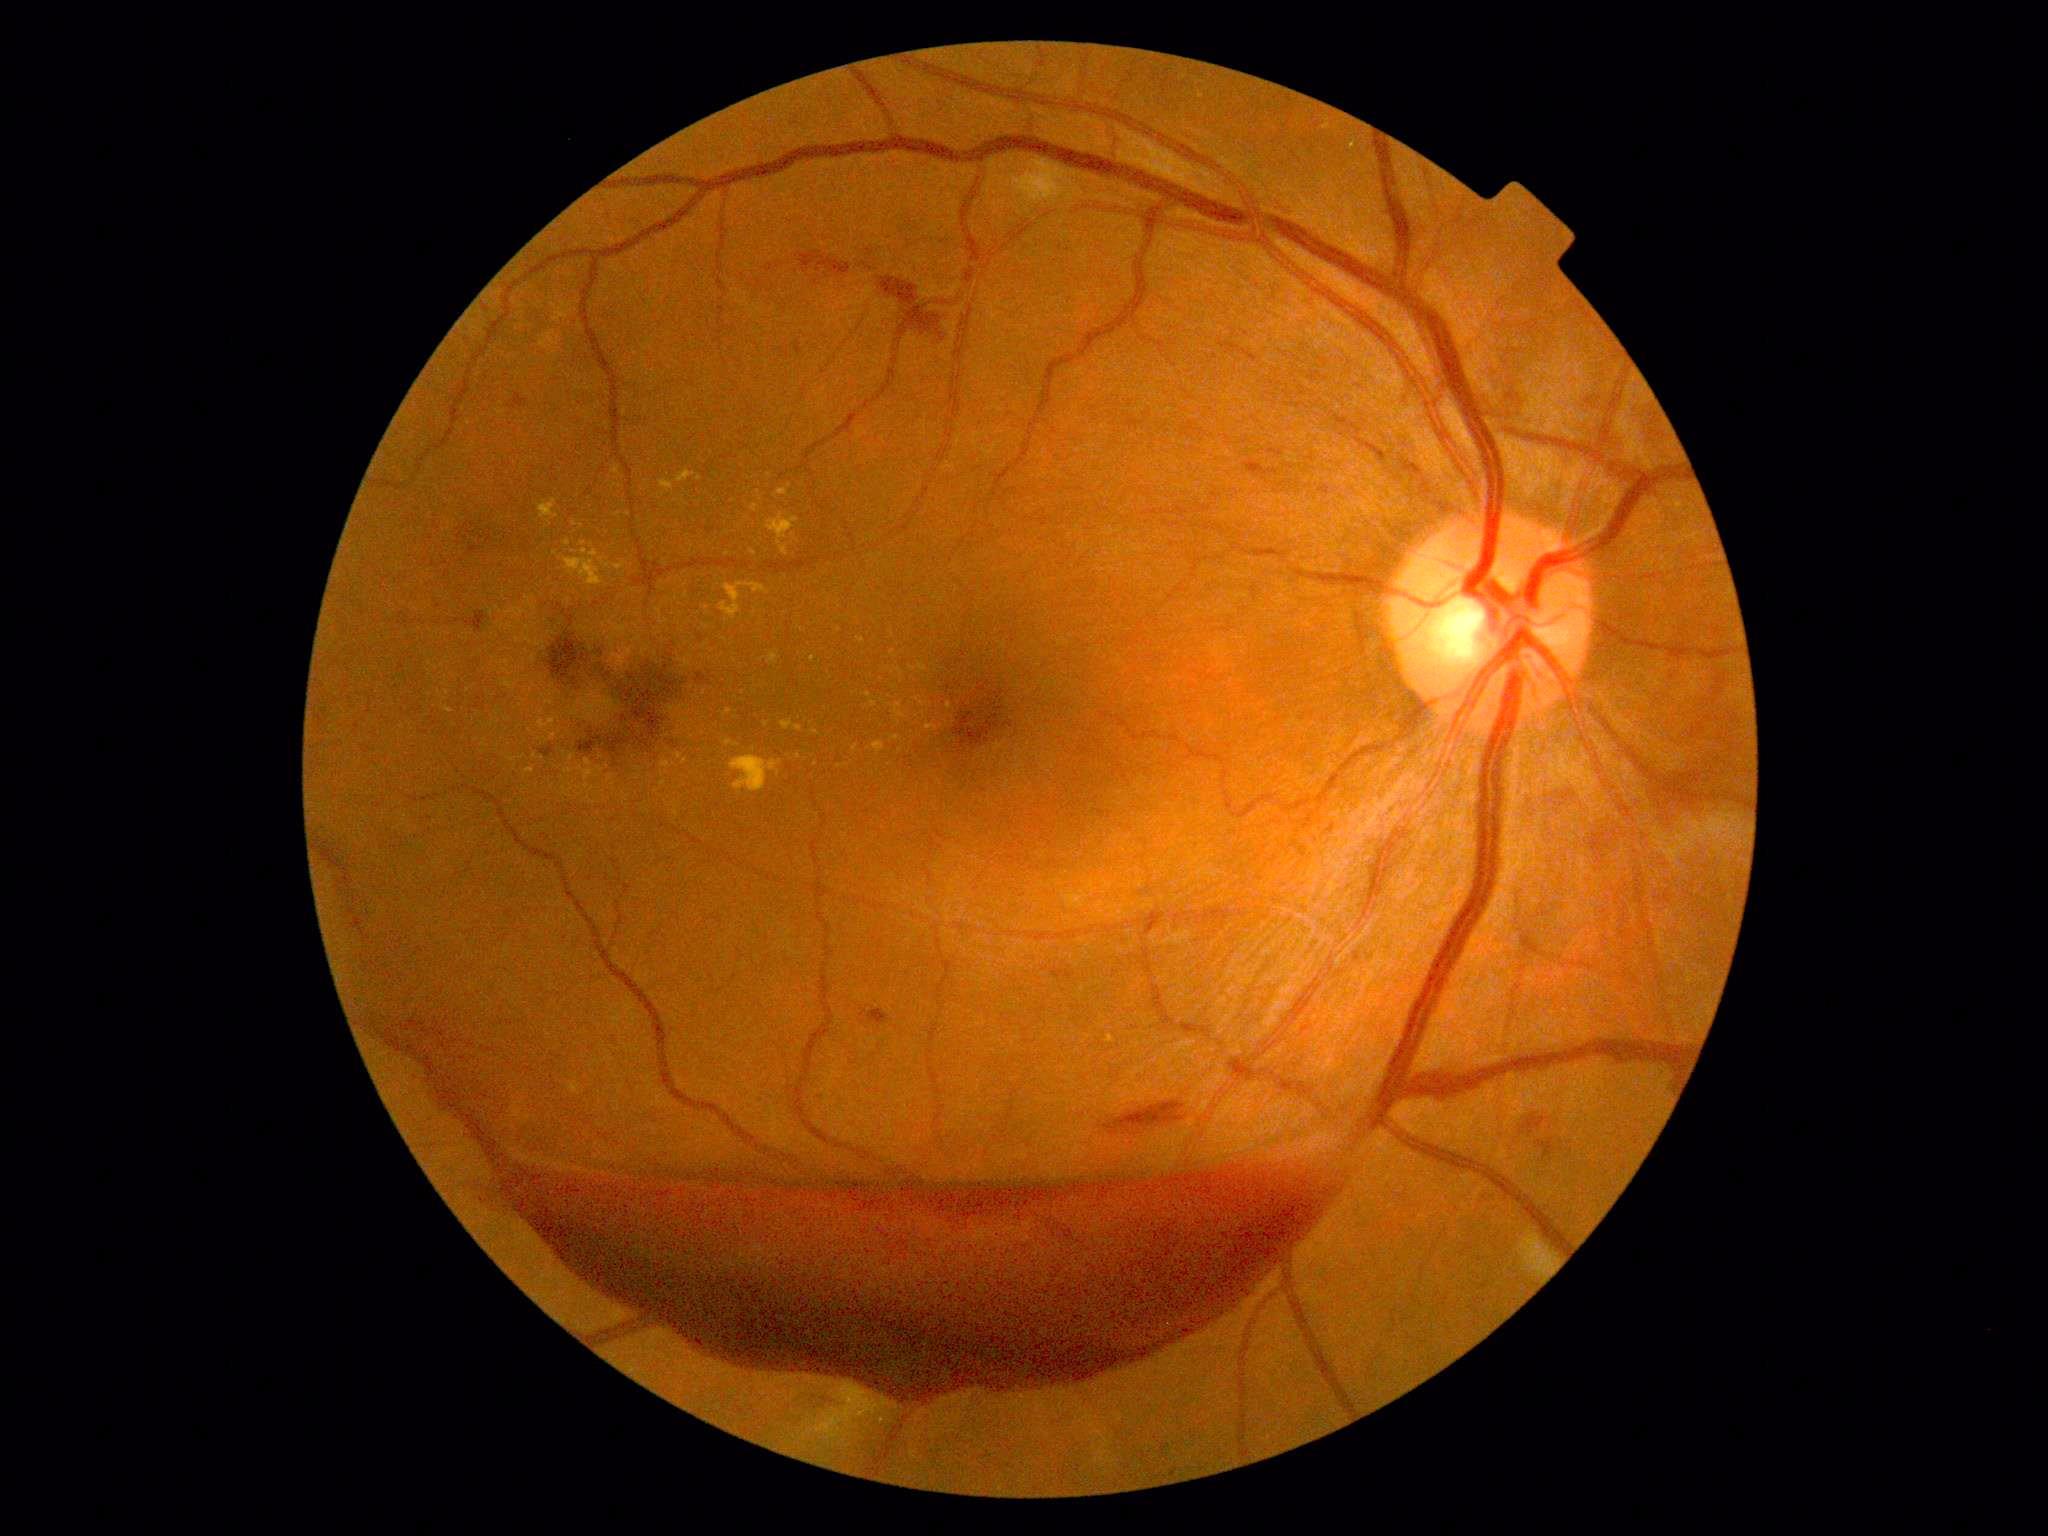 Diabetic retinopathy (DR) is grade 4 (PDR)
Representative lesions:
- hard exudates (EXs) (more not shown): [left=721, top=710, right=733, bottom=717] | [left=564, top=540, right=572, bottom=547] | [left=599, top=557, right=612, bottom=569] | [left=730, top=757, right=782, bottom=792] | [left=893, top=701, right=908, bottom=724] | [left=872, top=741, right=885, bottom=755] | [left=751, top=505, right=760, bottom=513]
- Small EXs near 895:687 | 618:515 | 874:704 | 856:693 | 753:553 | 661:588 | 840:630 | 735:661 | 790:486 | 582:794 | 579:788
- hemorrhages (HEs) (more not shown): [left=464, top=611, right=491, bottom=634] | [left=1253, top=549, right=1282, bottom=557] | [left=1051, top=967, right=1076, bottom=981] | [left=347, top=909, right=356, bottom=919] | [left=699, top=634, right=704, bottom=643] | [left=1591, top=830, right=1618, bottom=856] | [left=1219, top=338, right=1258, bottom=363] | [left=696, top=673, right=709, bottom=683] | [left=316, top=839, right=354, bottom=895] | [left=576, top=654, right=684, bottom=764] | [left=350, top=917, right=371, bottom=943] | [left=1404, top=459, right=1423, bottom=478] | [left=548, top=631, right=612, bottom=695] | [left=1535, top=1139, right=1557, bottom=1159]